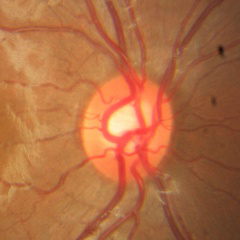 Assessment: no glaucomatous changes.